Fundus photo, 45° field of view, 2352x1568.
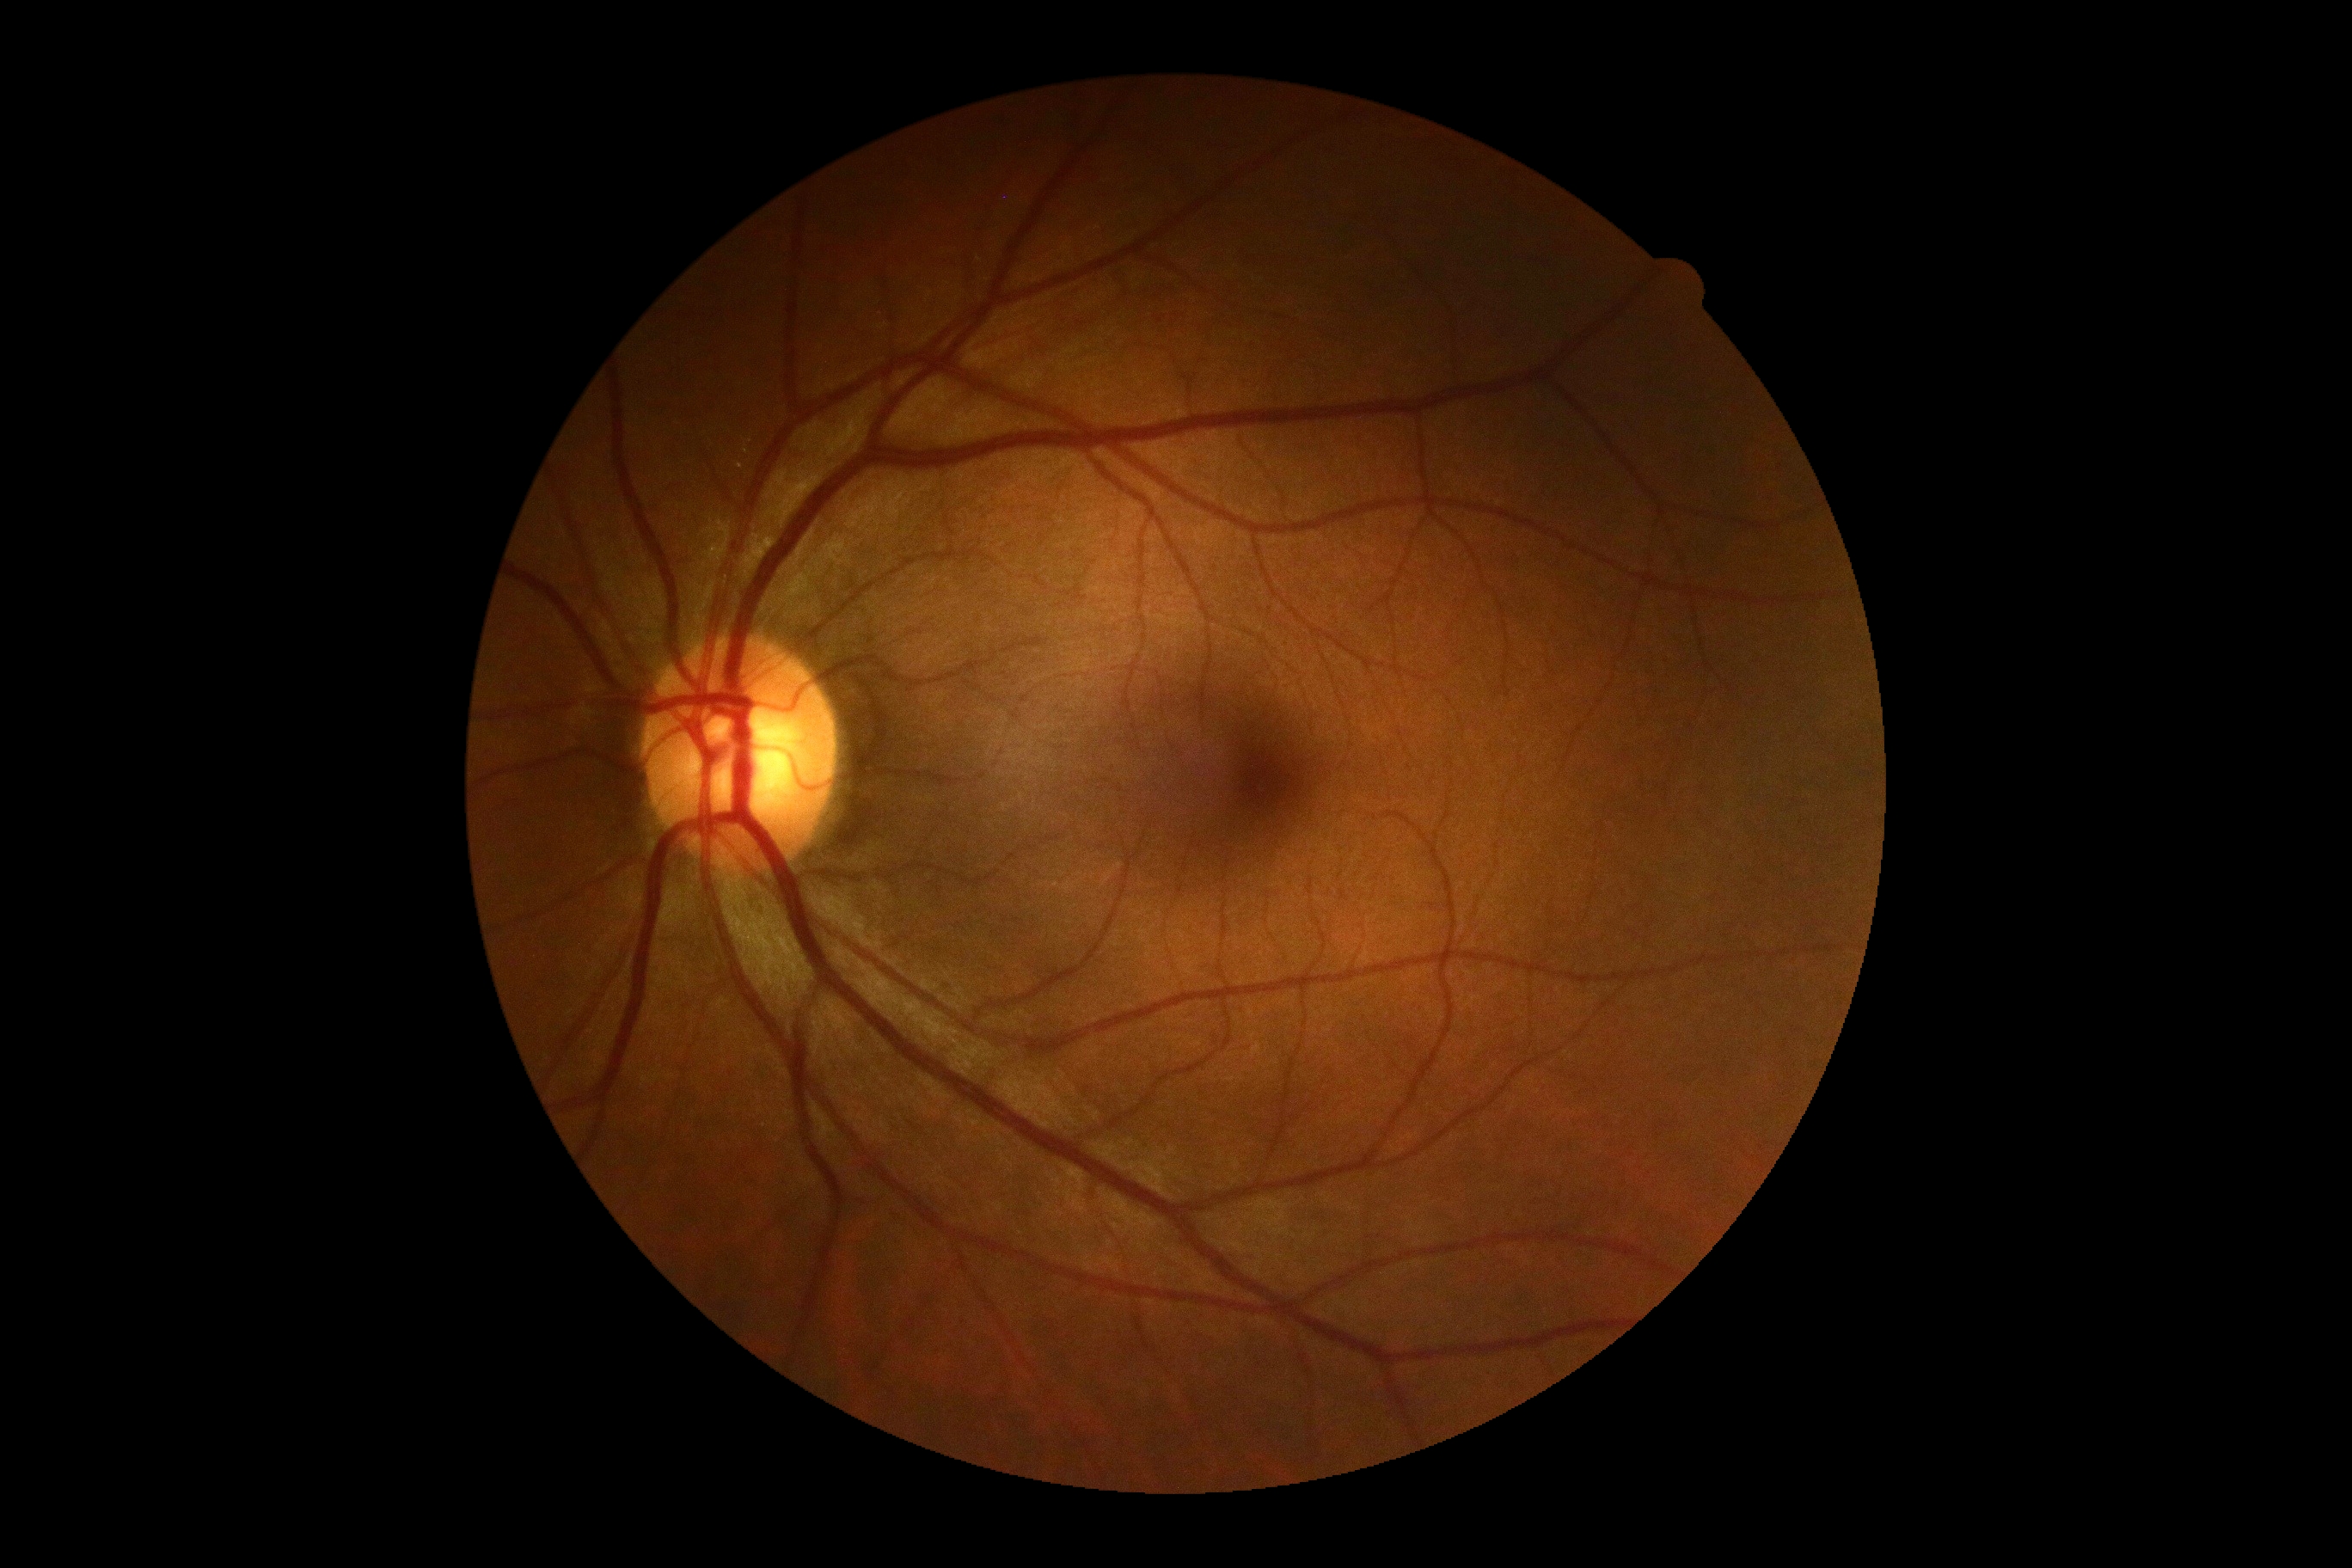 DR impression: no signs of DR; diabetic retinopathy (DR): grade 0 (no apparent retinopathy) — no visible signs of diabetic retinopathy.